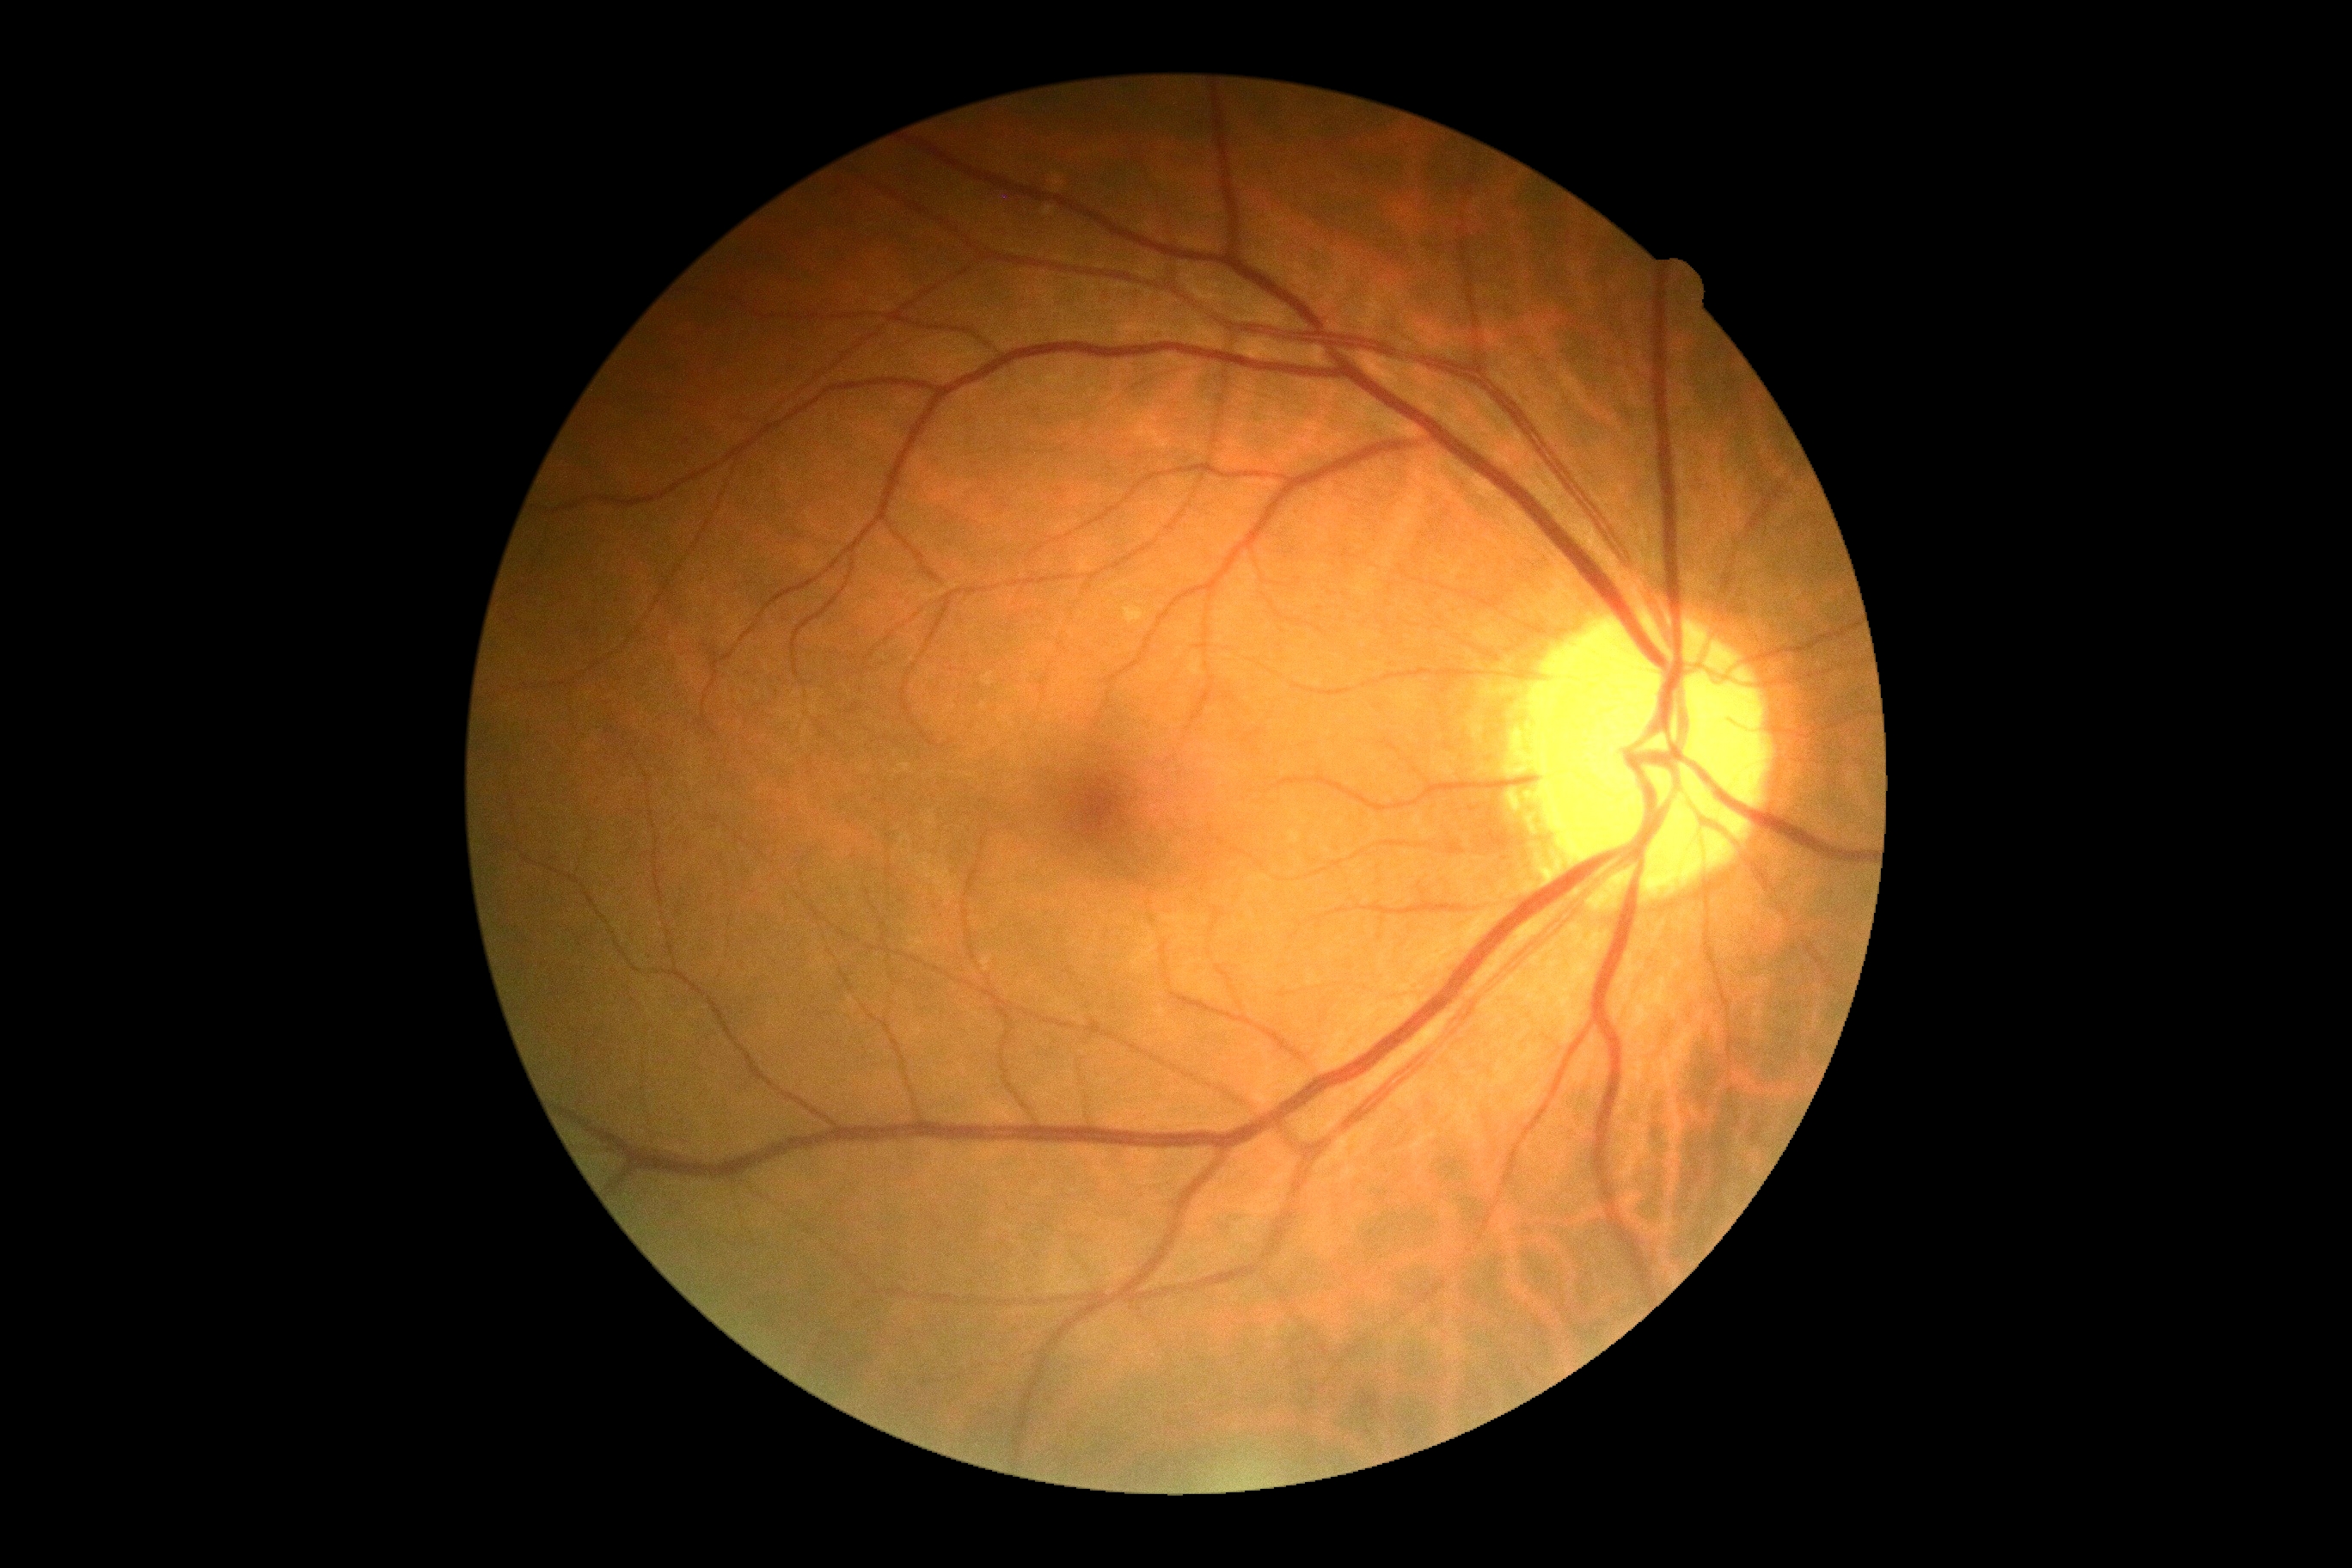
No diabetic retinal disease findings. Diabetic retinopathy is grade 0 (no apparent retinopathy) — no visible signs of diabetic retinopathy.